FOV: 45 degrees.
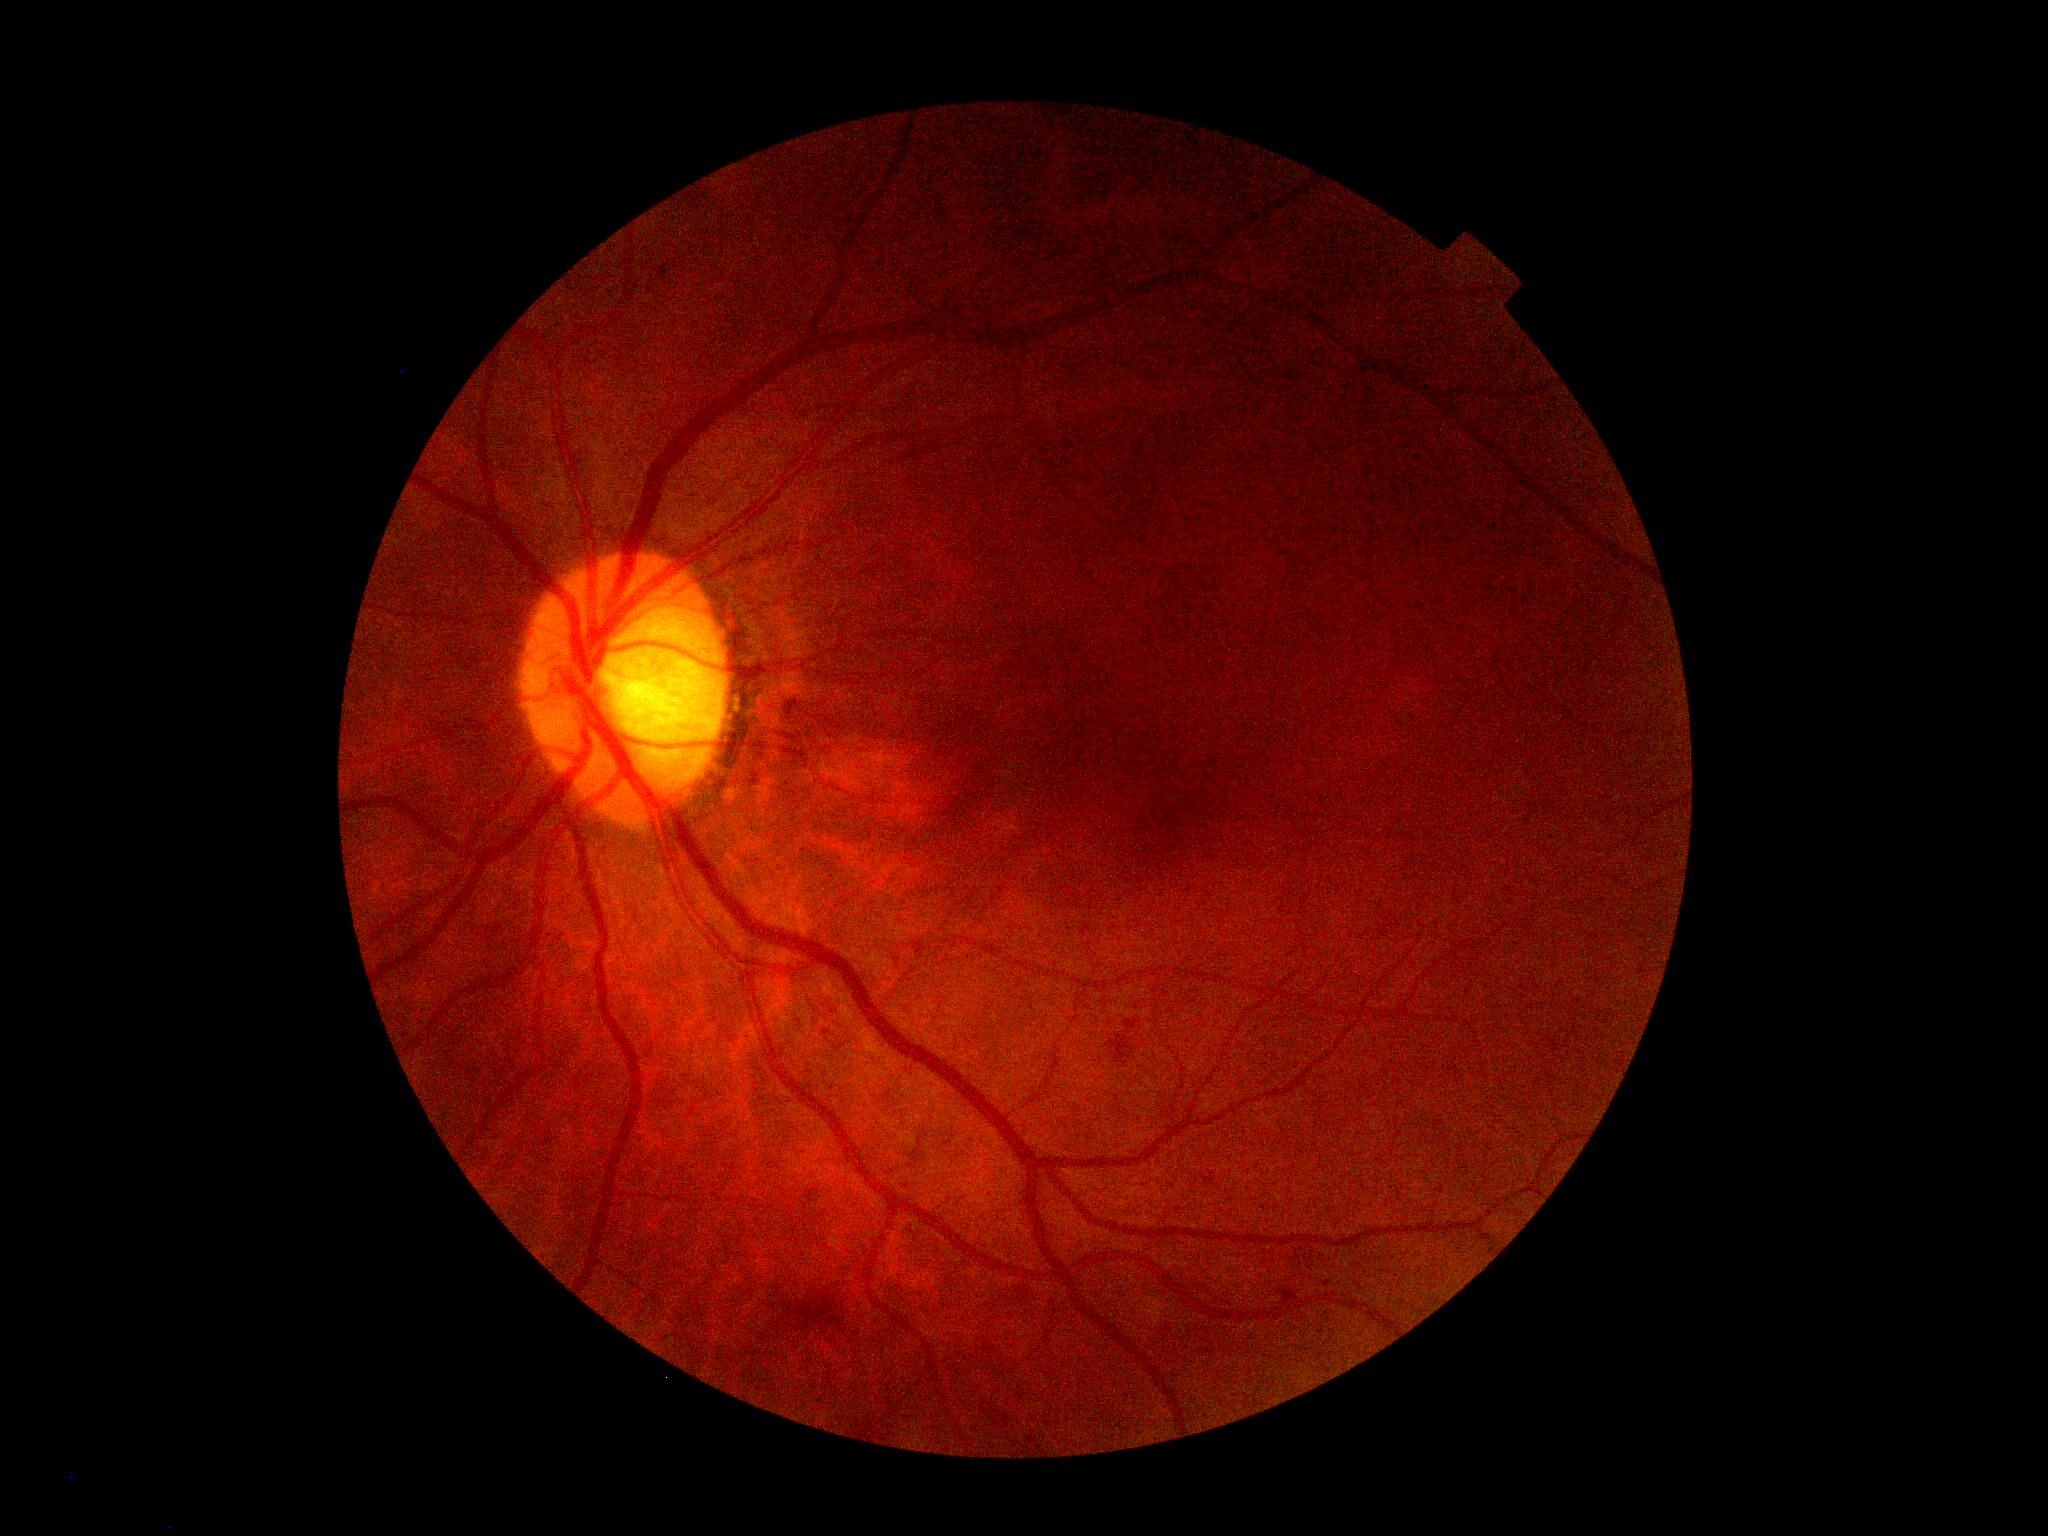

Retinopathy grade: 2.
The retinopathy is classified as non-proliferative diabetic retinopathy.